DR severity per modified Davis staging.
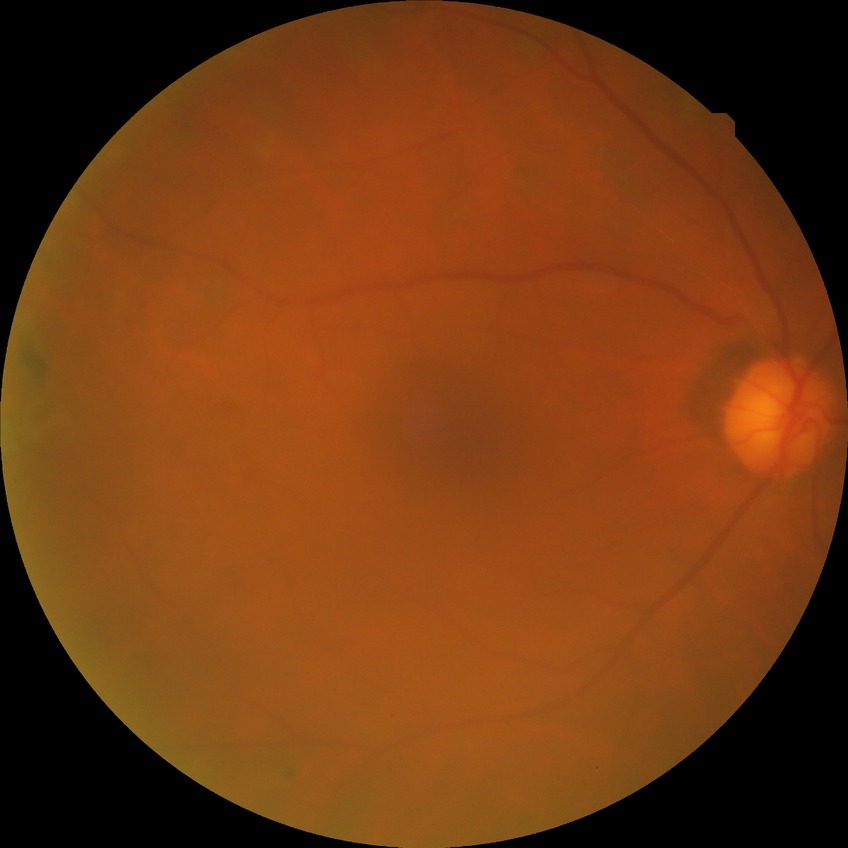

Diabetic retinopathy (DR) is proliferative diabetic retinopathy (PDR).